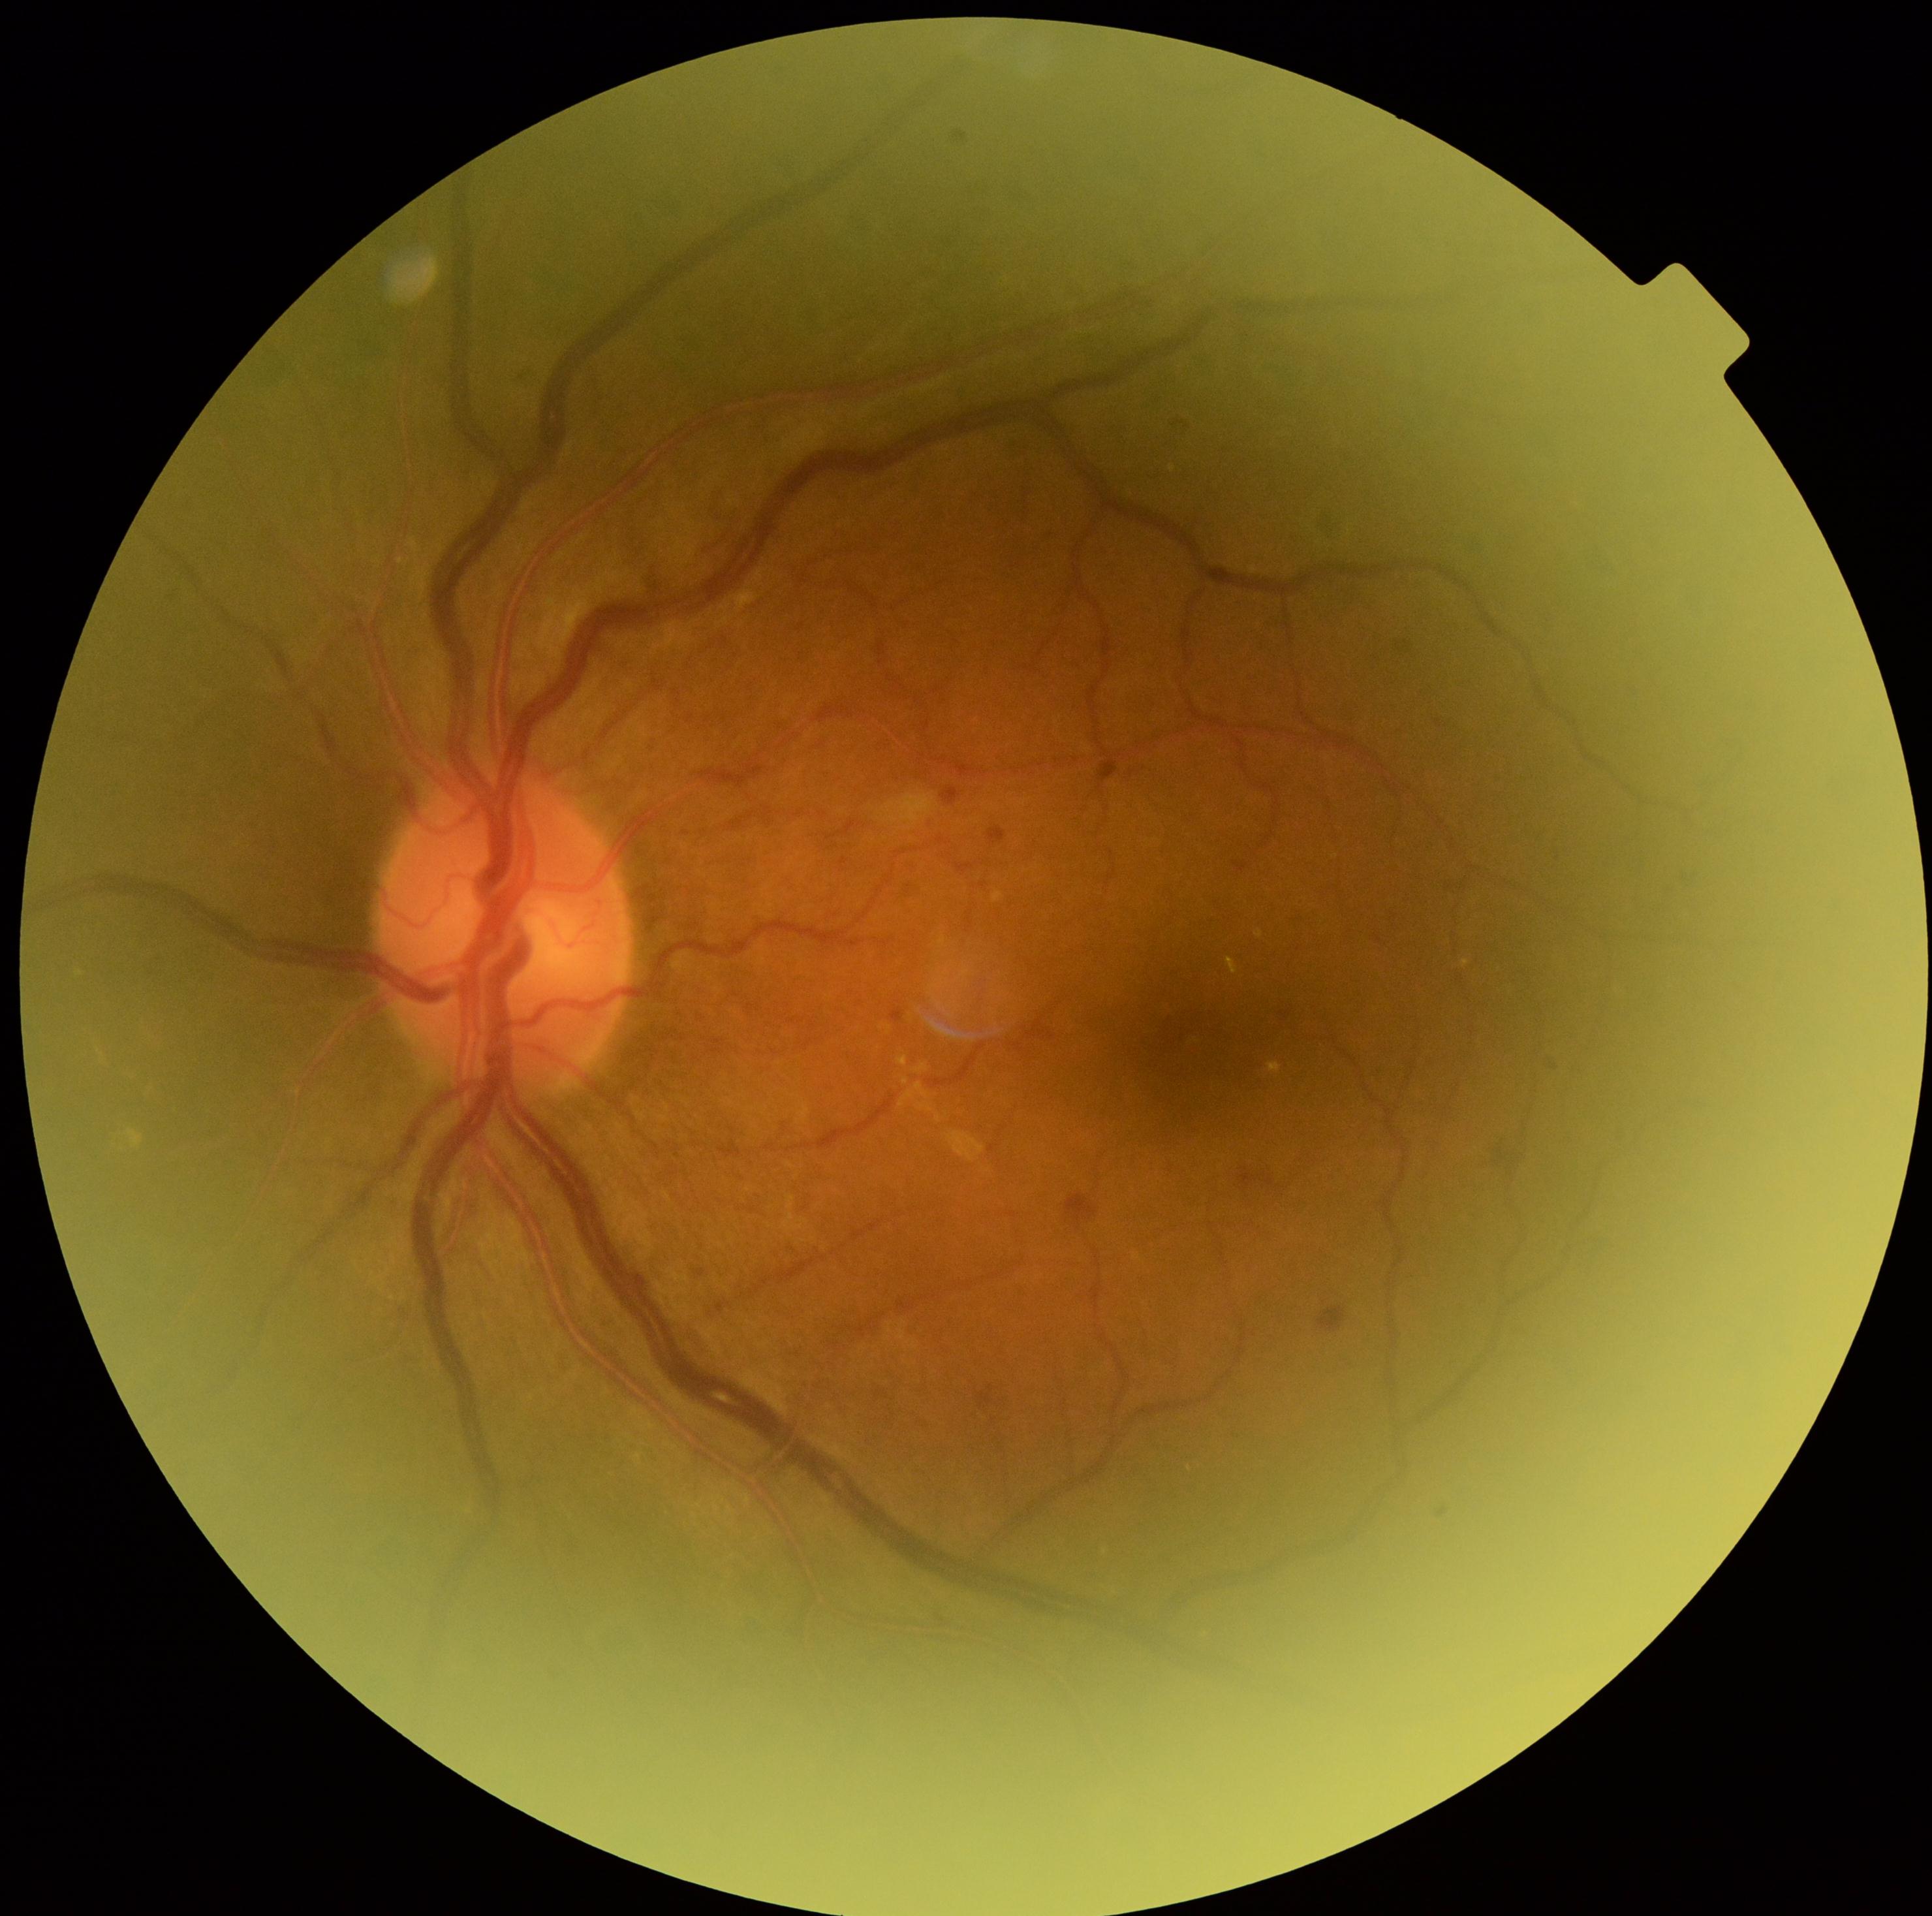 Diabetic retinopathy (DR): moderate NPDR (grade 2). Microaneurysms (MAs) identified at {"left": 798, "top": 624, "right": 806, "bottom": 633}, {"left": 1174, "top": 420, "right": 1190, "bottom": 430}, {"left": 875, "top": 1390, "right": 884, "bottom": 1401}, {"left": 1437, "top": 721, "right": 1442, "bottom": 729}, {"left": 698, "top": 1269, "right": 706, "bottom": 1277}, {"left": 958, "top": 864, "right": 974, "bottom": 873}, {"left": 1280, "top": 1012, "right": 1292, "bottom": 1022}, {"left": 942, "top": 787, "right": 961, "bottom": 807}, {"left": 892, "top": 1008, "right": 905, "bottom": 1022}, {"left": 977, "top": 1385, "right": 997, "bottom": 1409}, {"left": 1236, "top": 862, "right": 1249, "bottom": 873}, {"left": 989, "top": 826, "right": 1007, "bottom": 846}. Smaller MAs around x=1380 y=940, x=1398 y=647, x=1554 y=1068. Hard exudates (EXs) identified at {"left": 1268, "top": 1061, "right": 1281, "bottom": 1073}, {"left": 736, "top": 591, "right": 758, "bottom": 614}, {"left": 126, "top": 1129, "right": 143, "bottom": 1149}. Hemorrhages (HEs) identified at {"left": 1239, "top": 1169, "right": 1275, "bottom": 1191}, {"left": 1493, "top": 1148, "right": 1510, "bottom": 1166}, {"left": 1318, "top": 1307, "right": 1348, "bottom": 1333}, {"left": 1066, "top": 1192, "right": 1098, "bottom": 1230}. No soft exudates (SEs) identified.